1240 by 1240 pixels; wide-field fundus photograph from neonatal ROP screening — 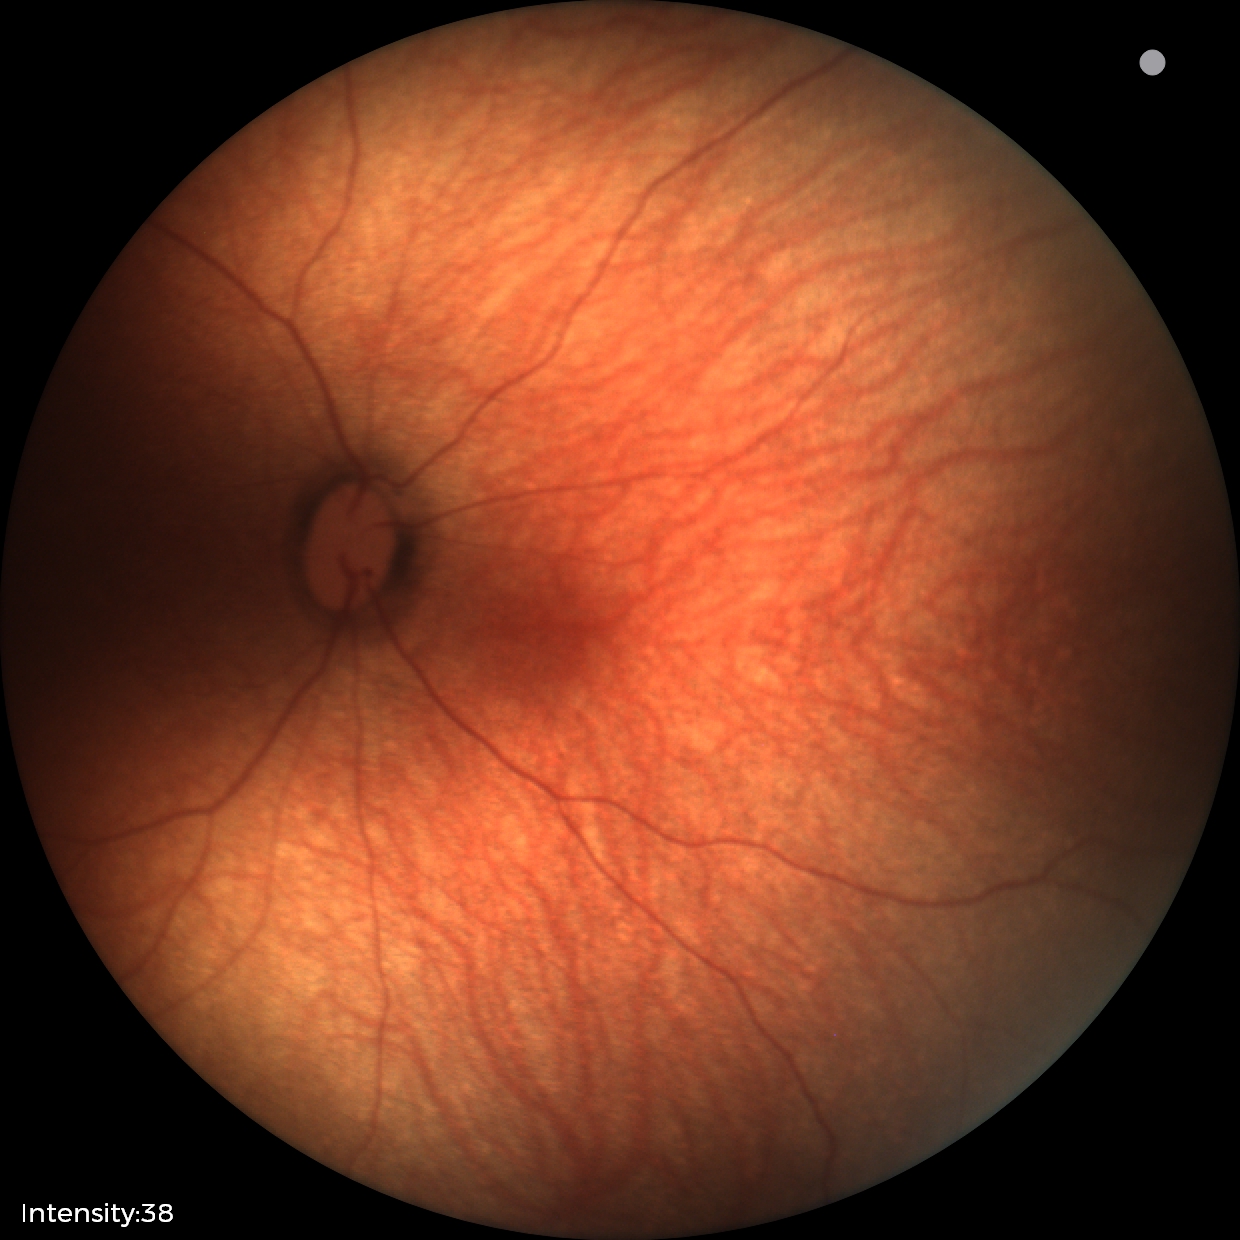
Diagnosis: normal retinal appearance.